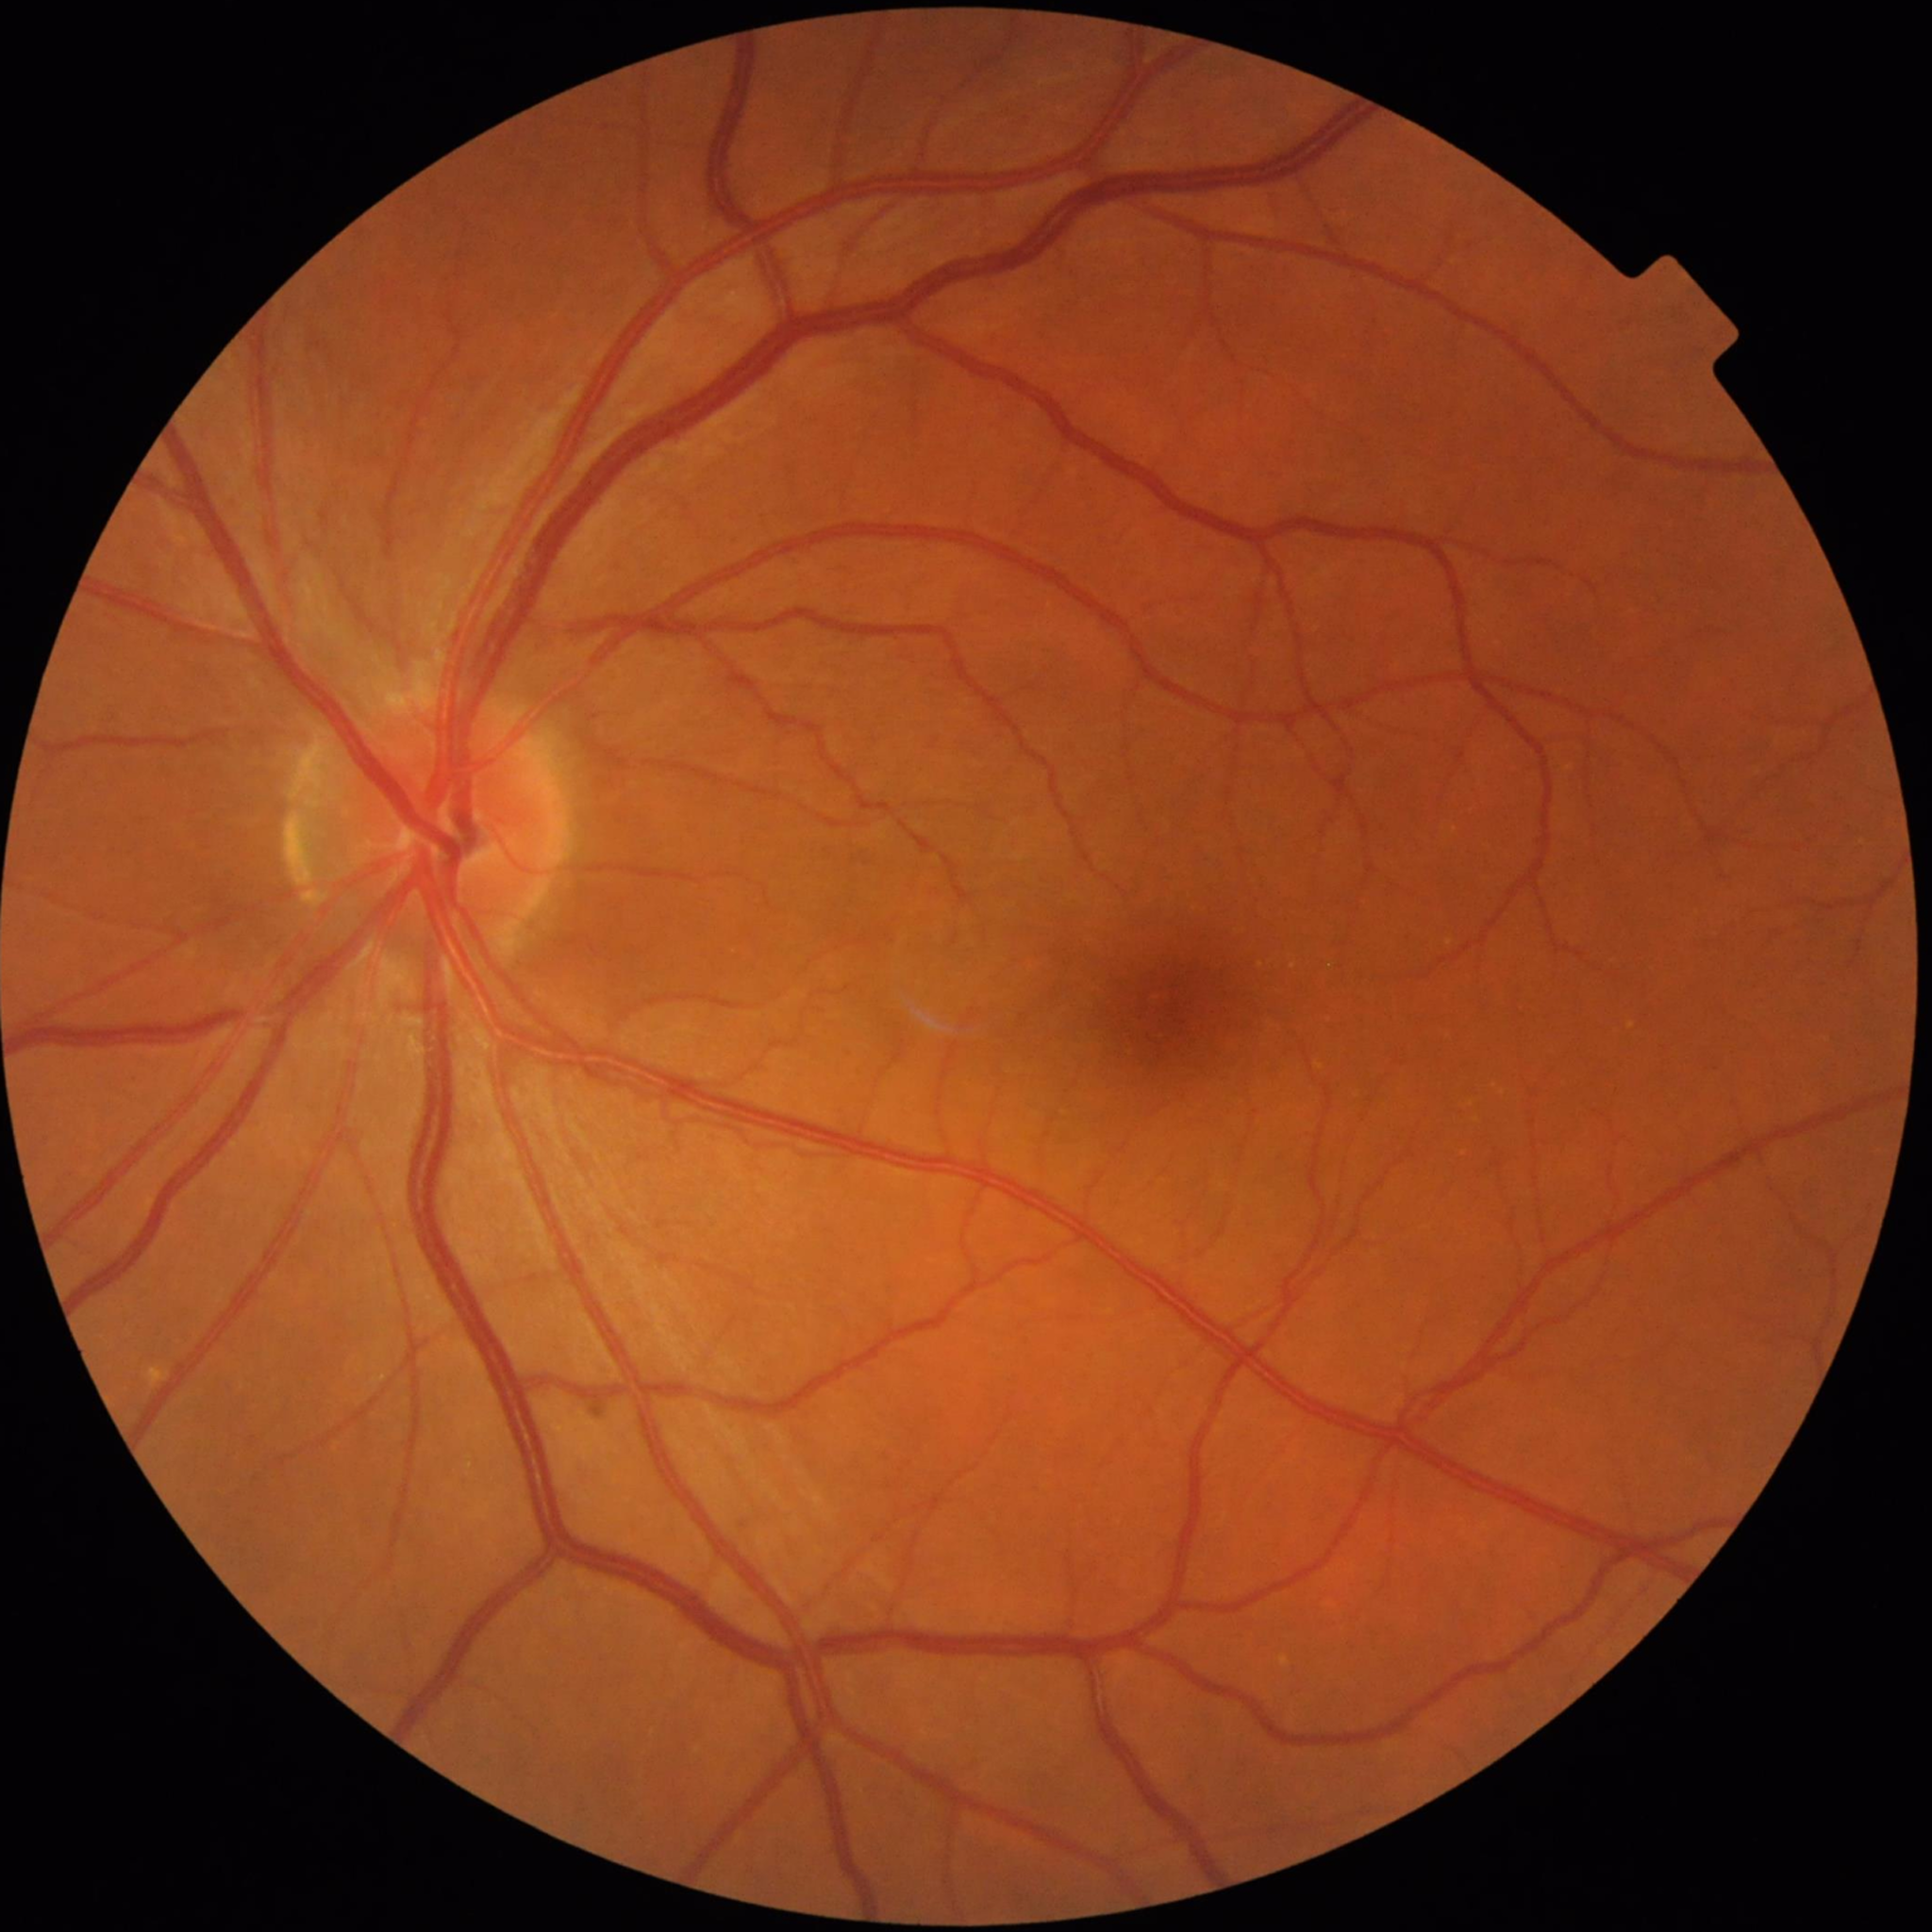
Disease class: no AMD, DR, or glaucomatous findings